Retinal fundus photograph:
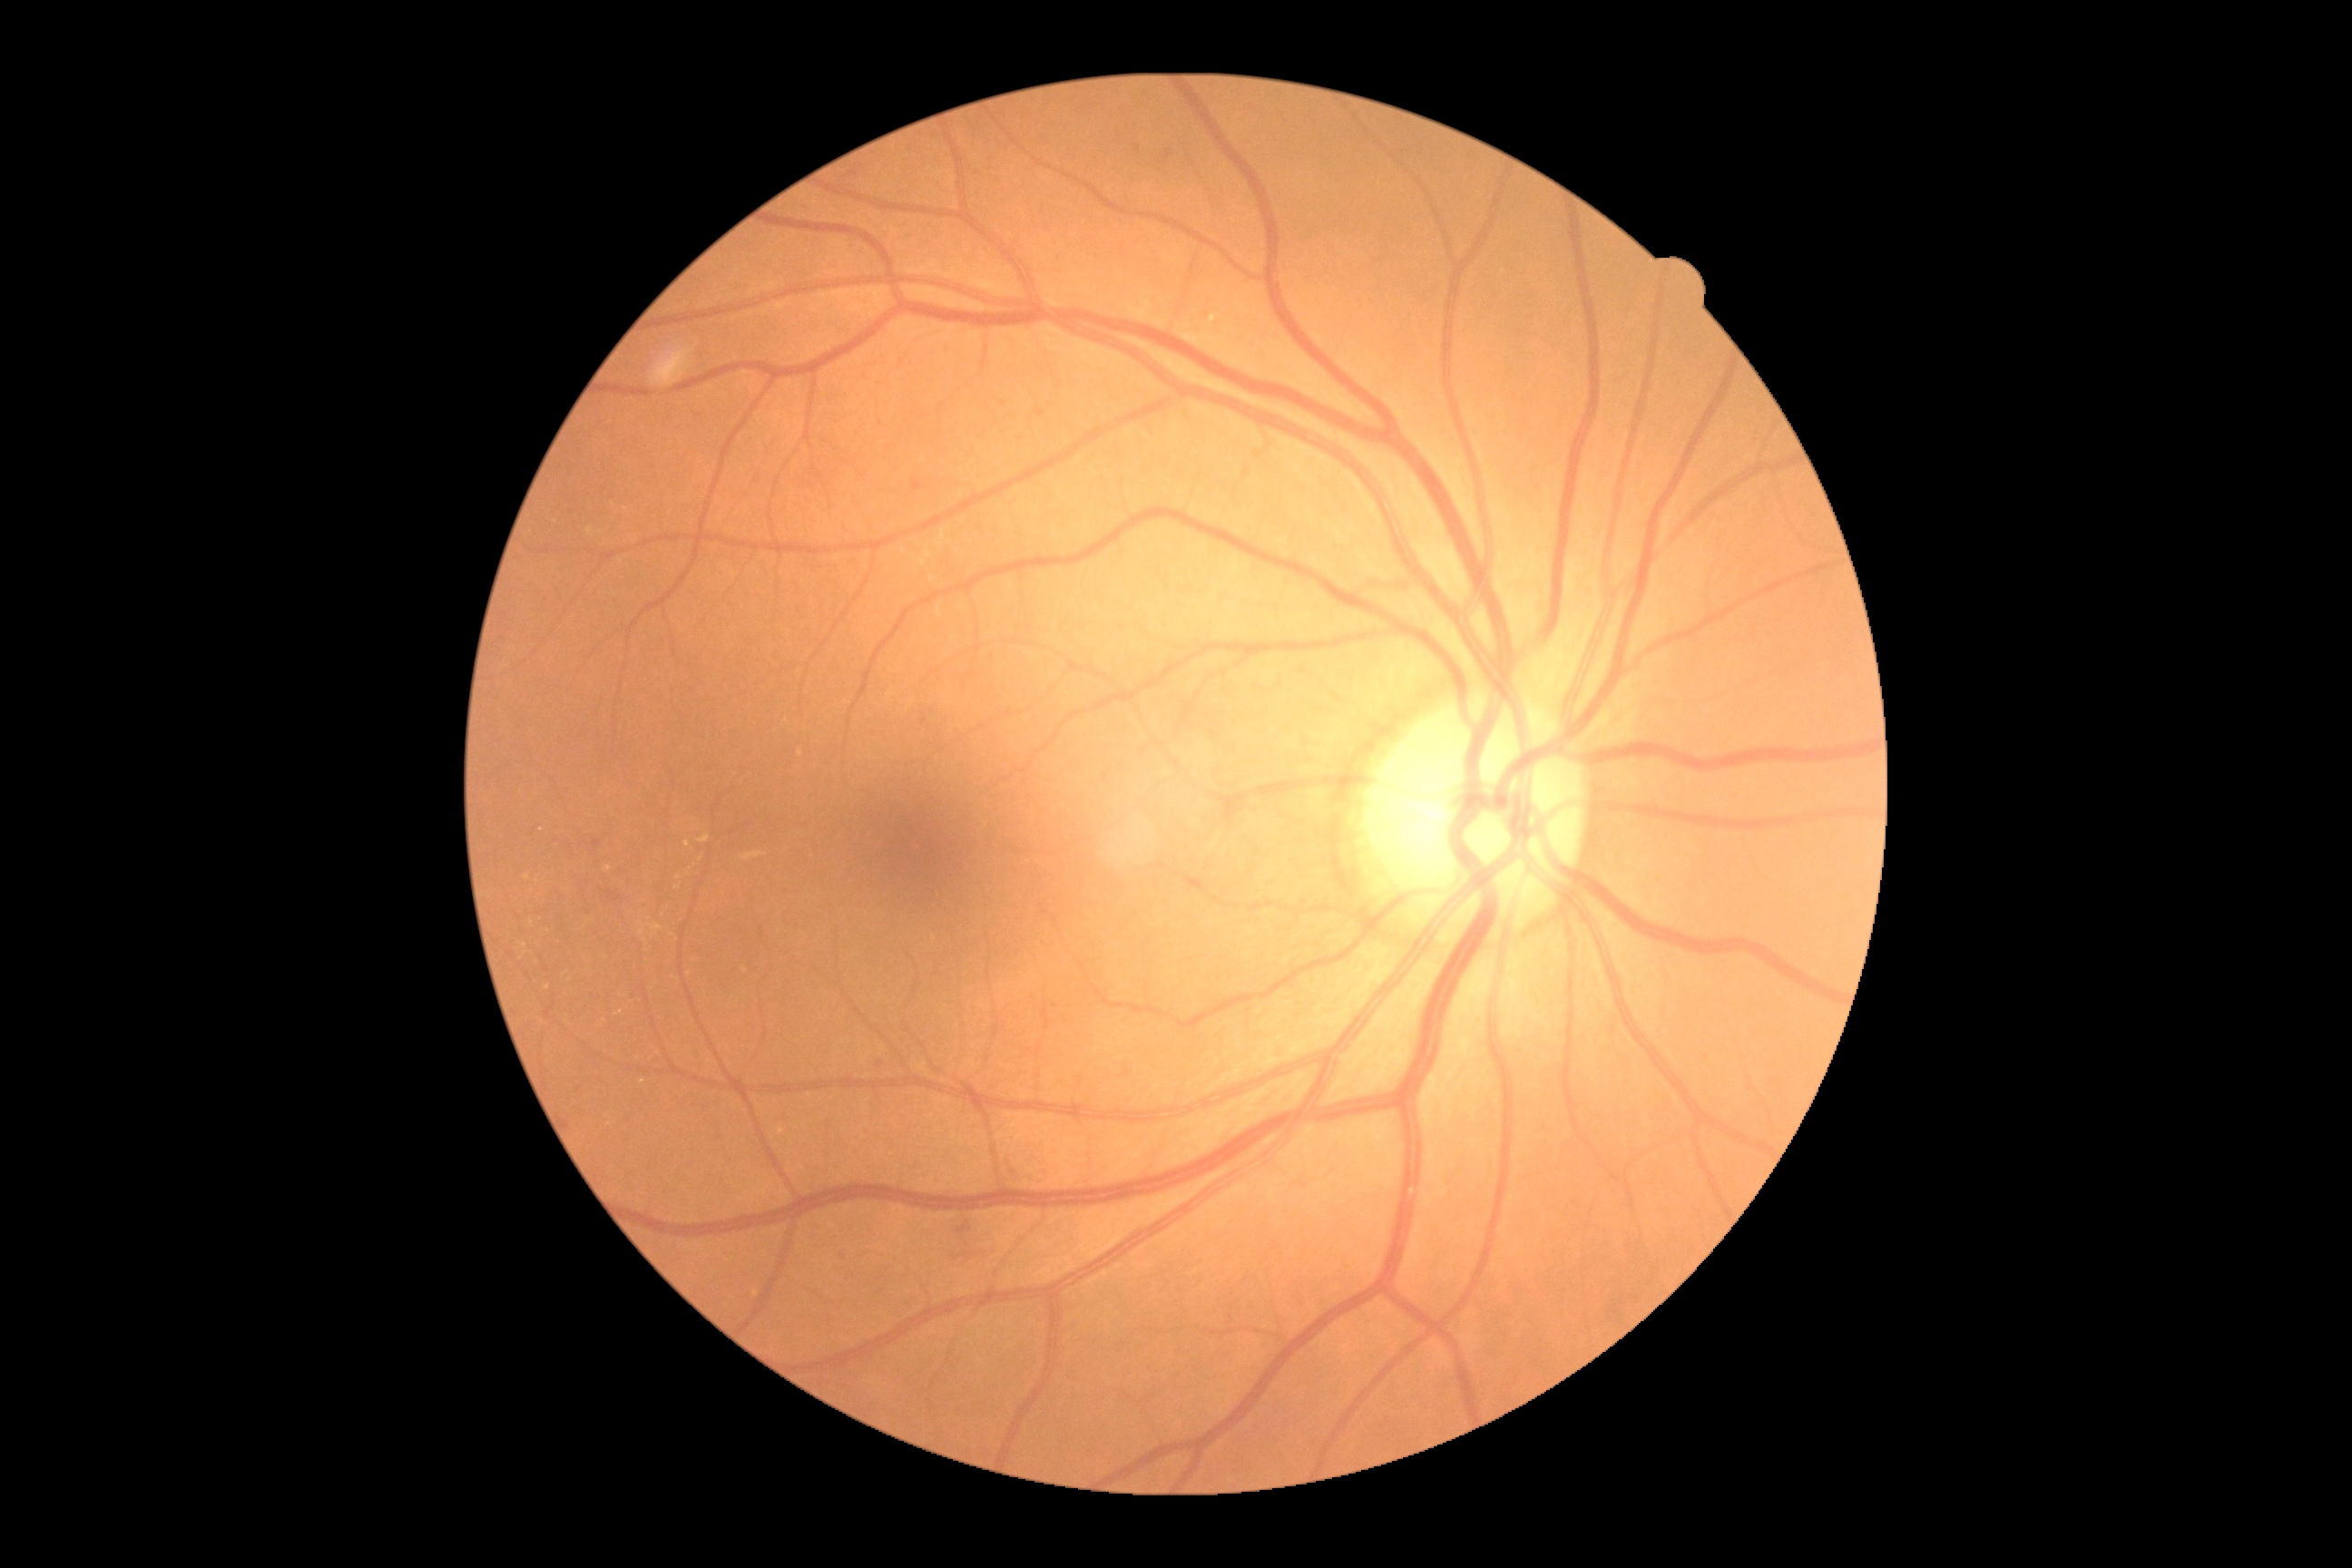 DR: grade 2 (moderate NPDR).